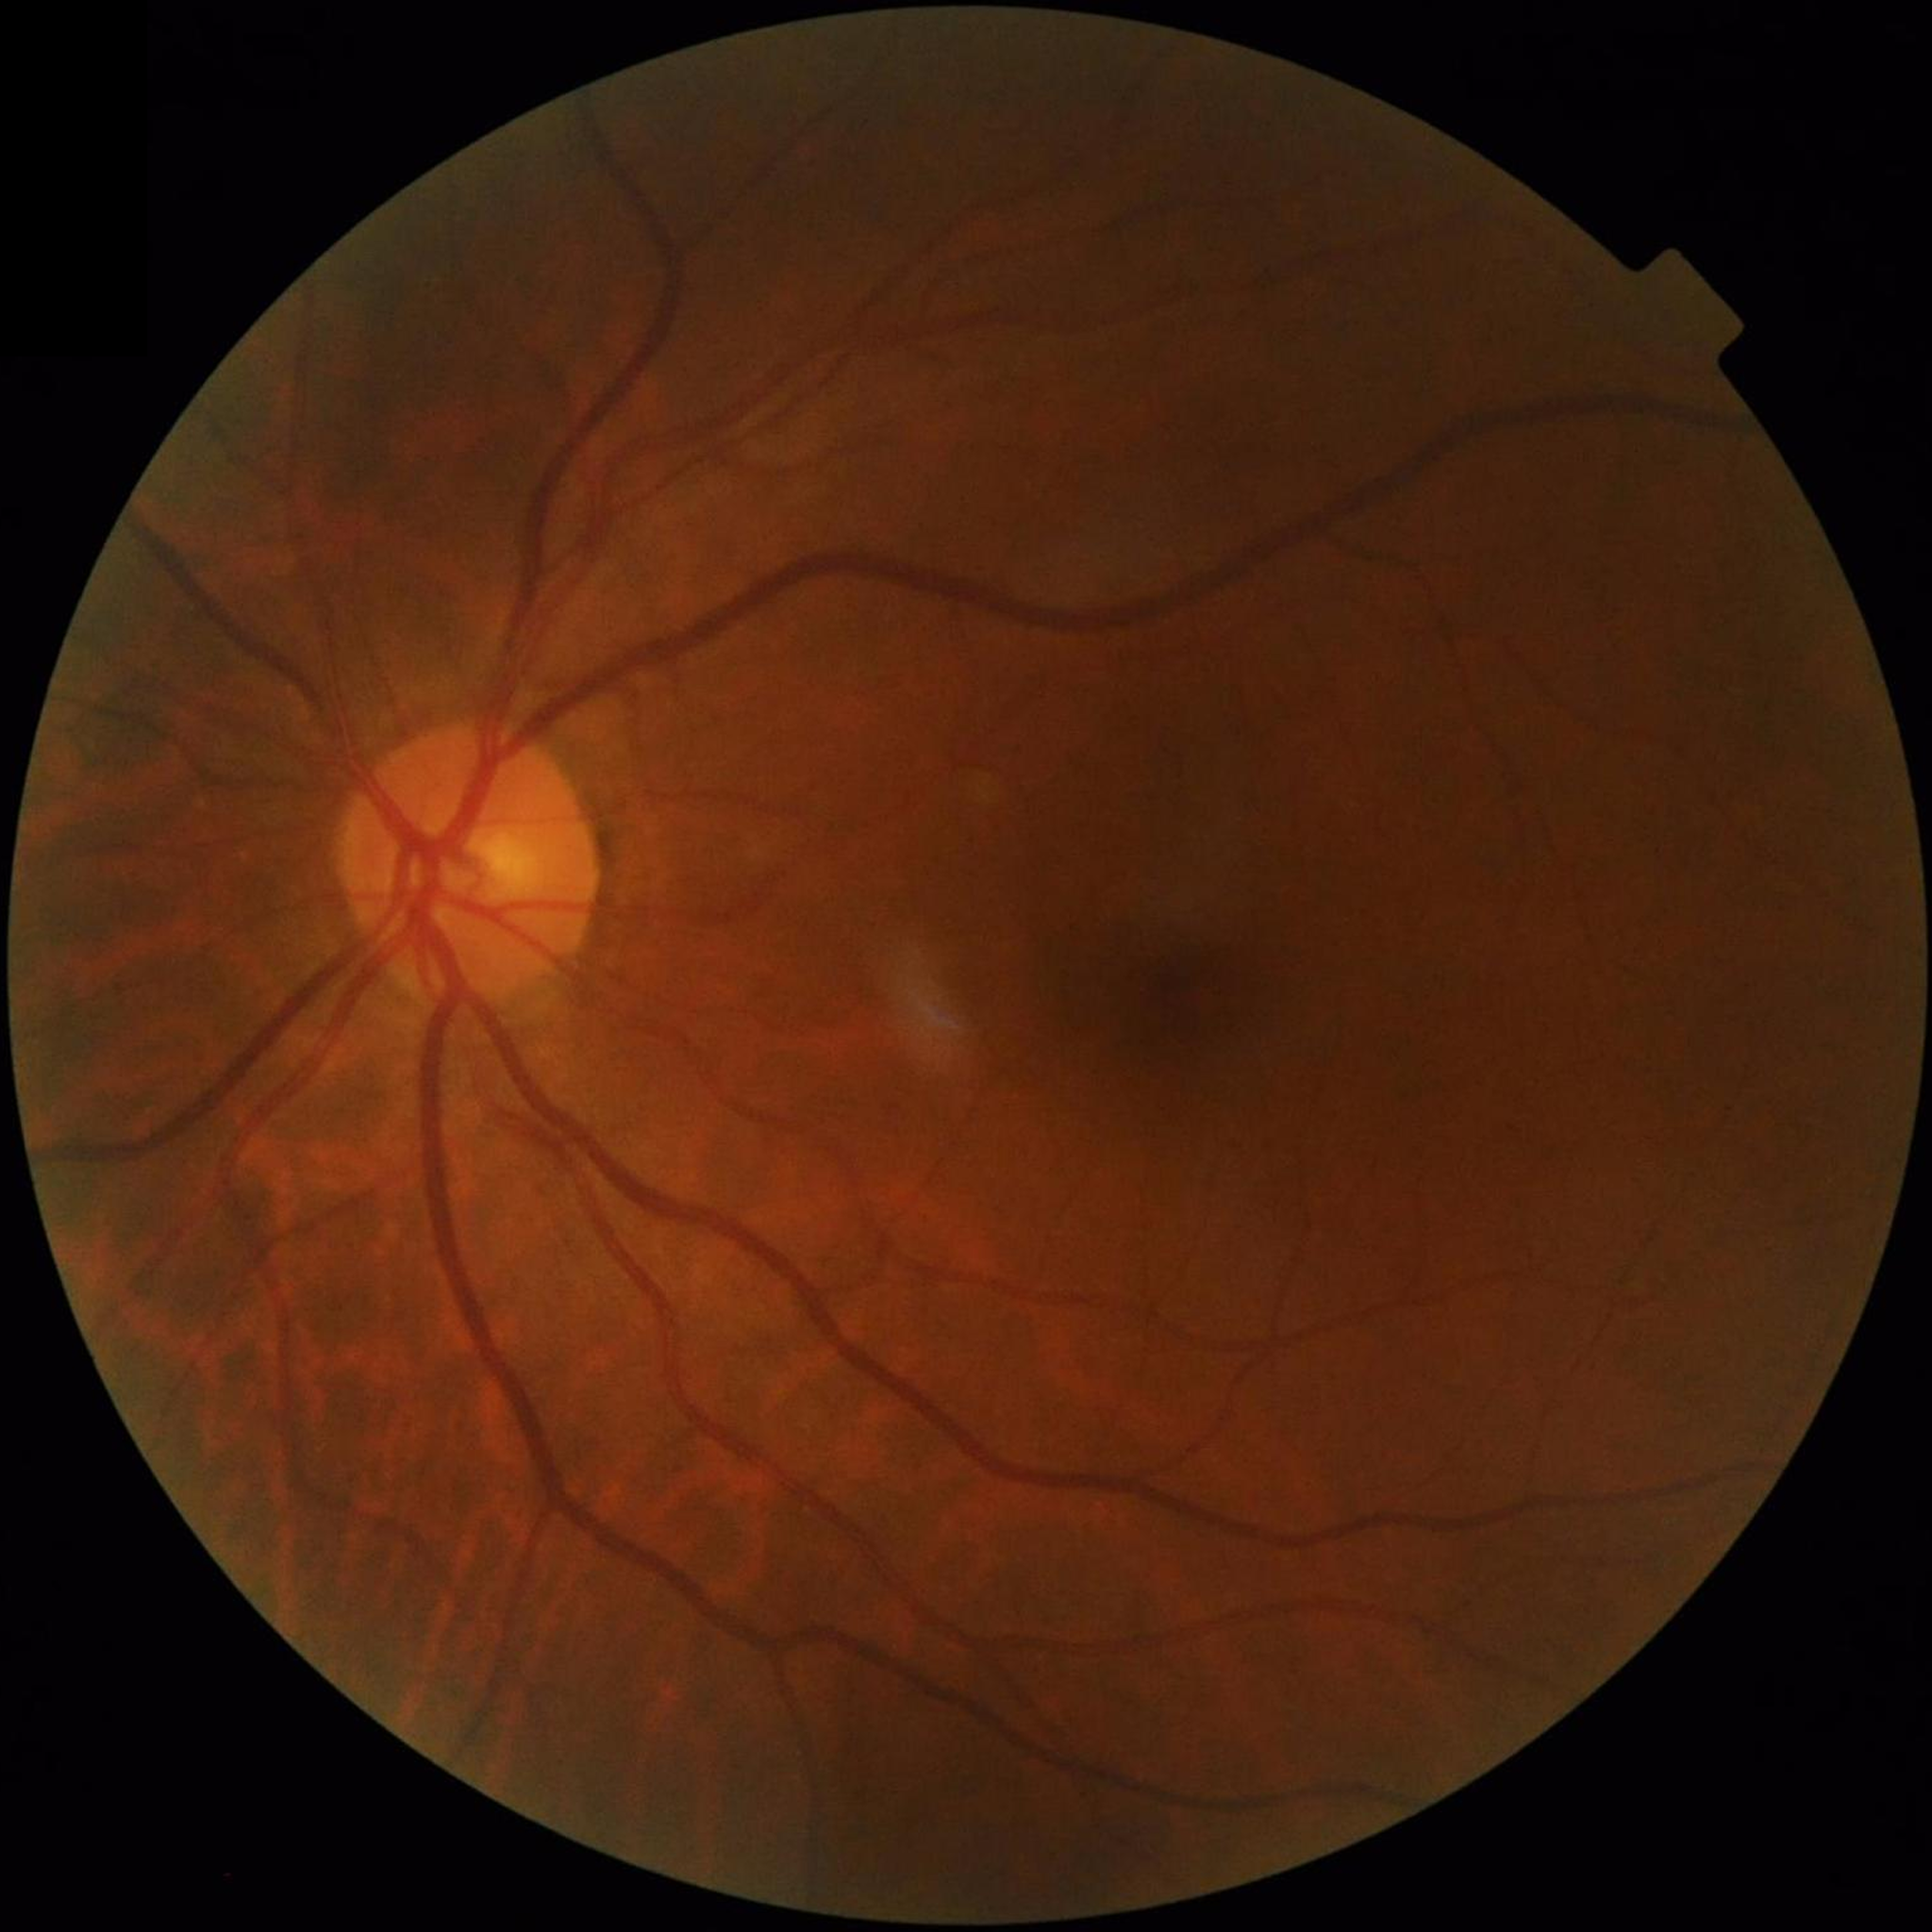
Diagnosis: no AMD, DR, or glaucomatous findings.